FOV: 45 degrees. NIDEK AFC-230 fundus camera. Graded on the modified Davis scale. Nonmydriatic
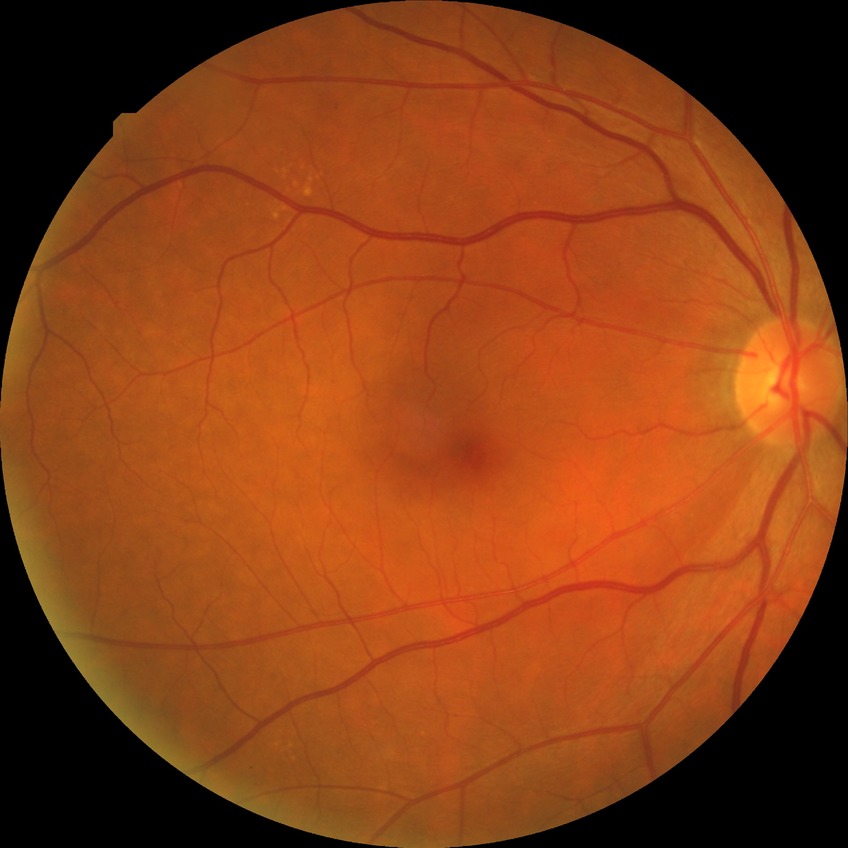 Retinopathy stage: no diabetic retinopathy.